Wide-field fundus photograph of an infant; acquired on the Natus RetCam Envision; 1440 by 1080 pixels.
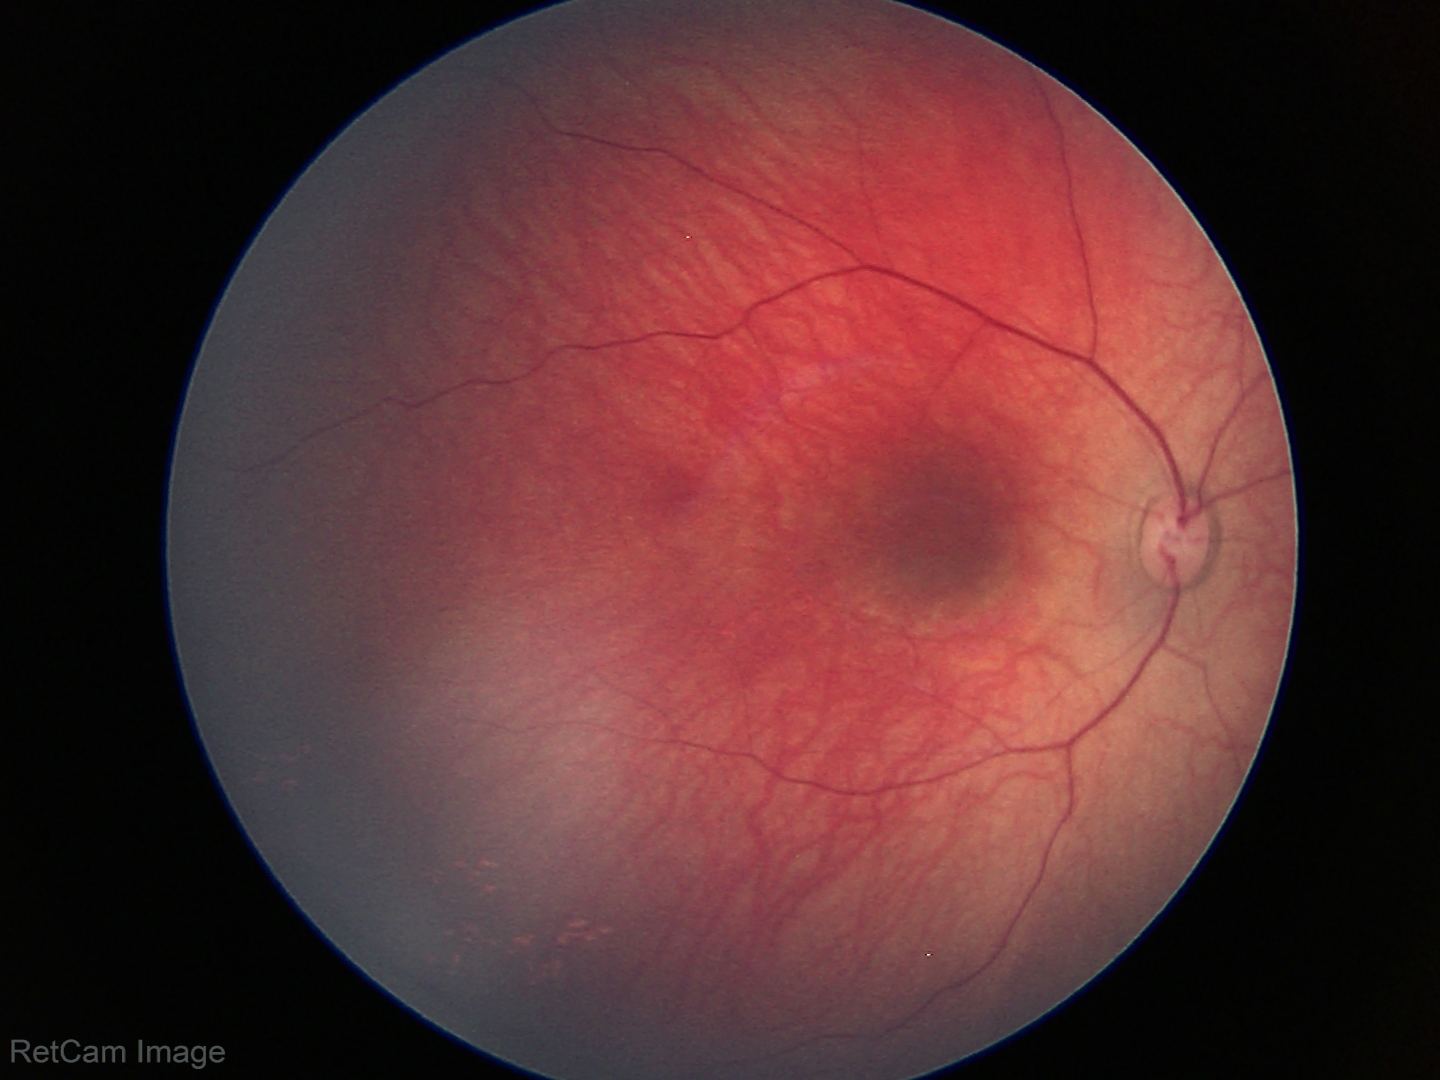

Physiological retinal appearance for postconceptual age.